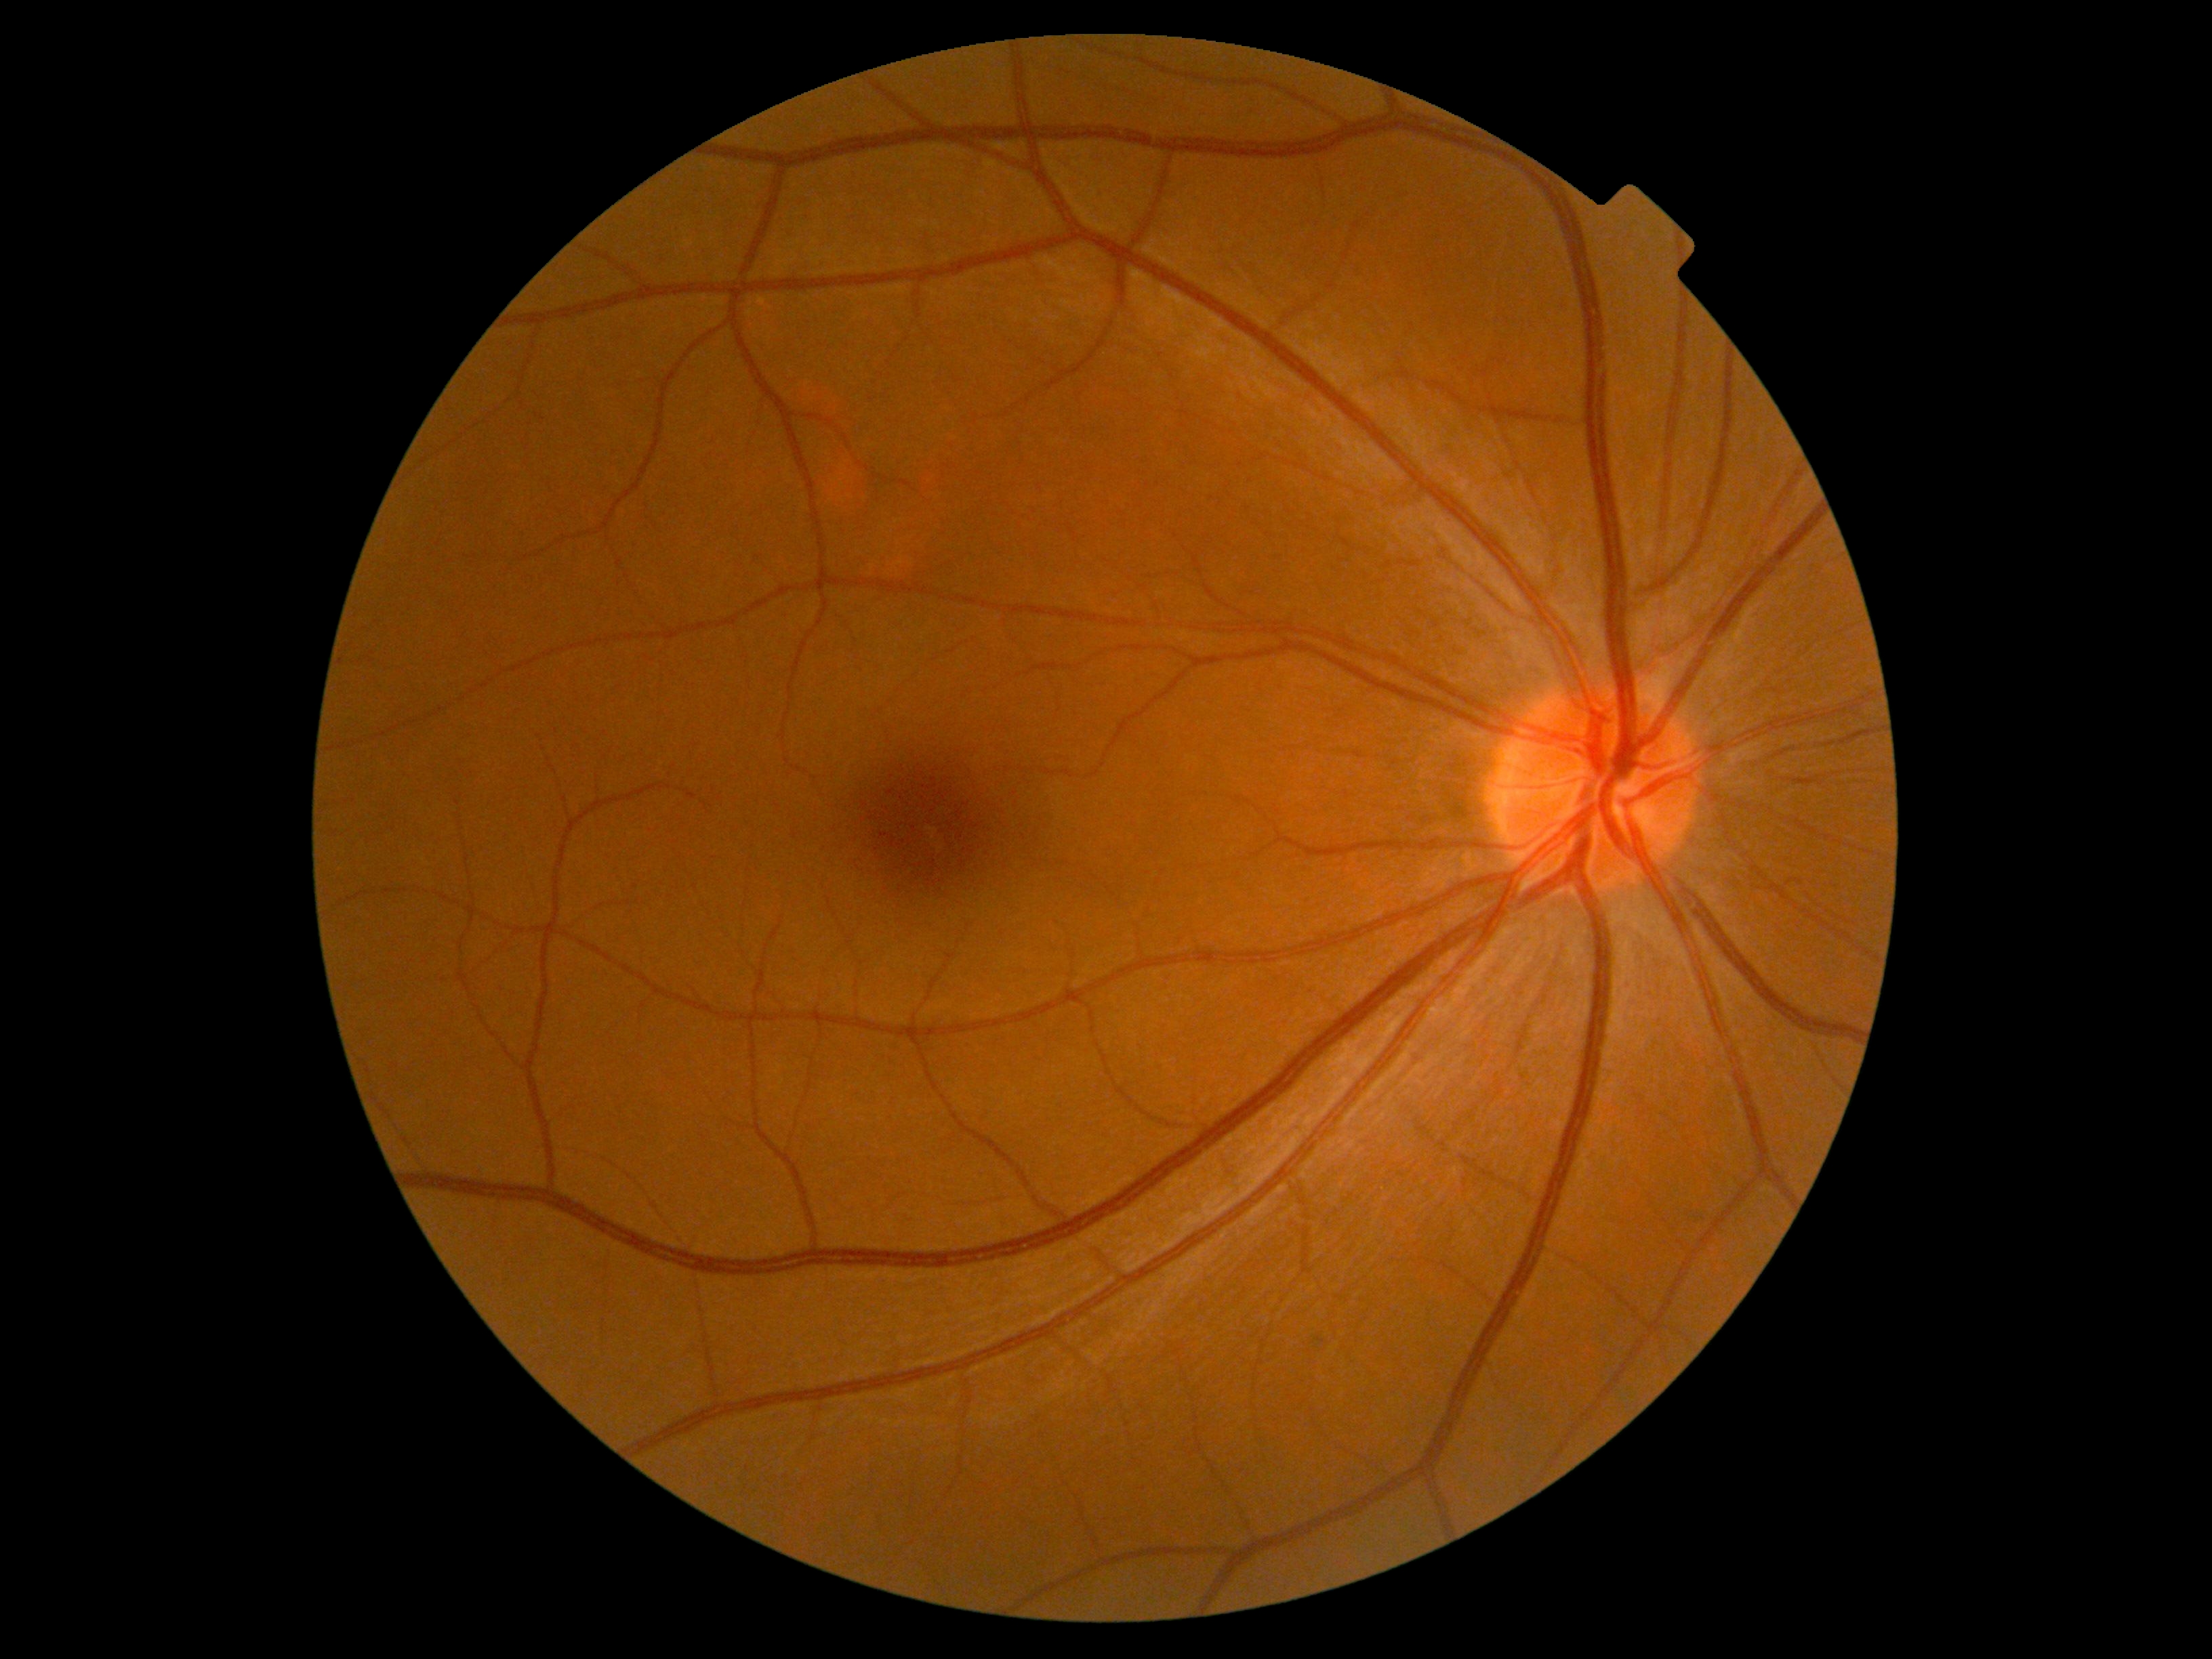
Diabetic retinopathy severity is no apparent retinopathy (grade 0).